Image size 640x480 · infant wide-field retinal image — 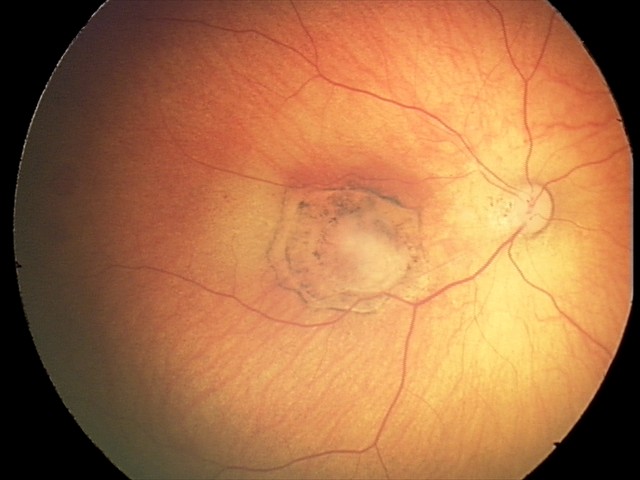 Screening series with toxoplasmosis chorioretinitis.